Image size 1659x2212, camera: Remidio Fundus on Phone (FOP) camera:
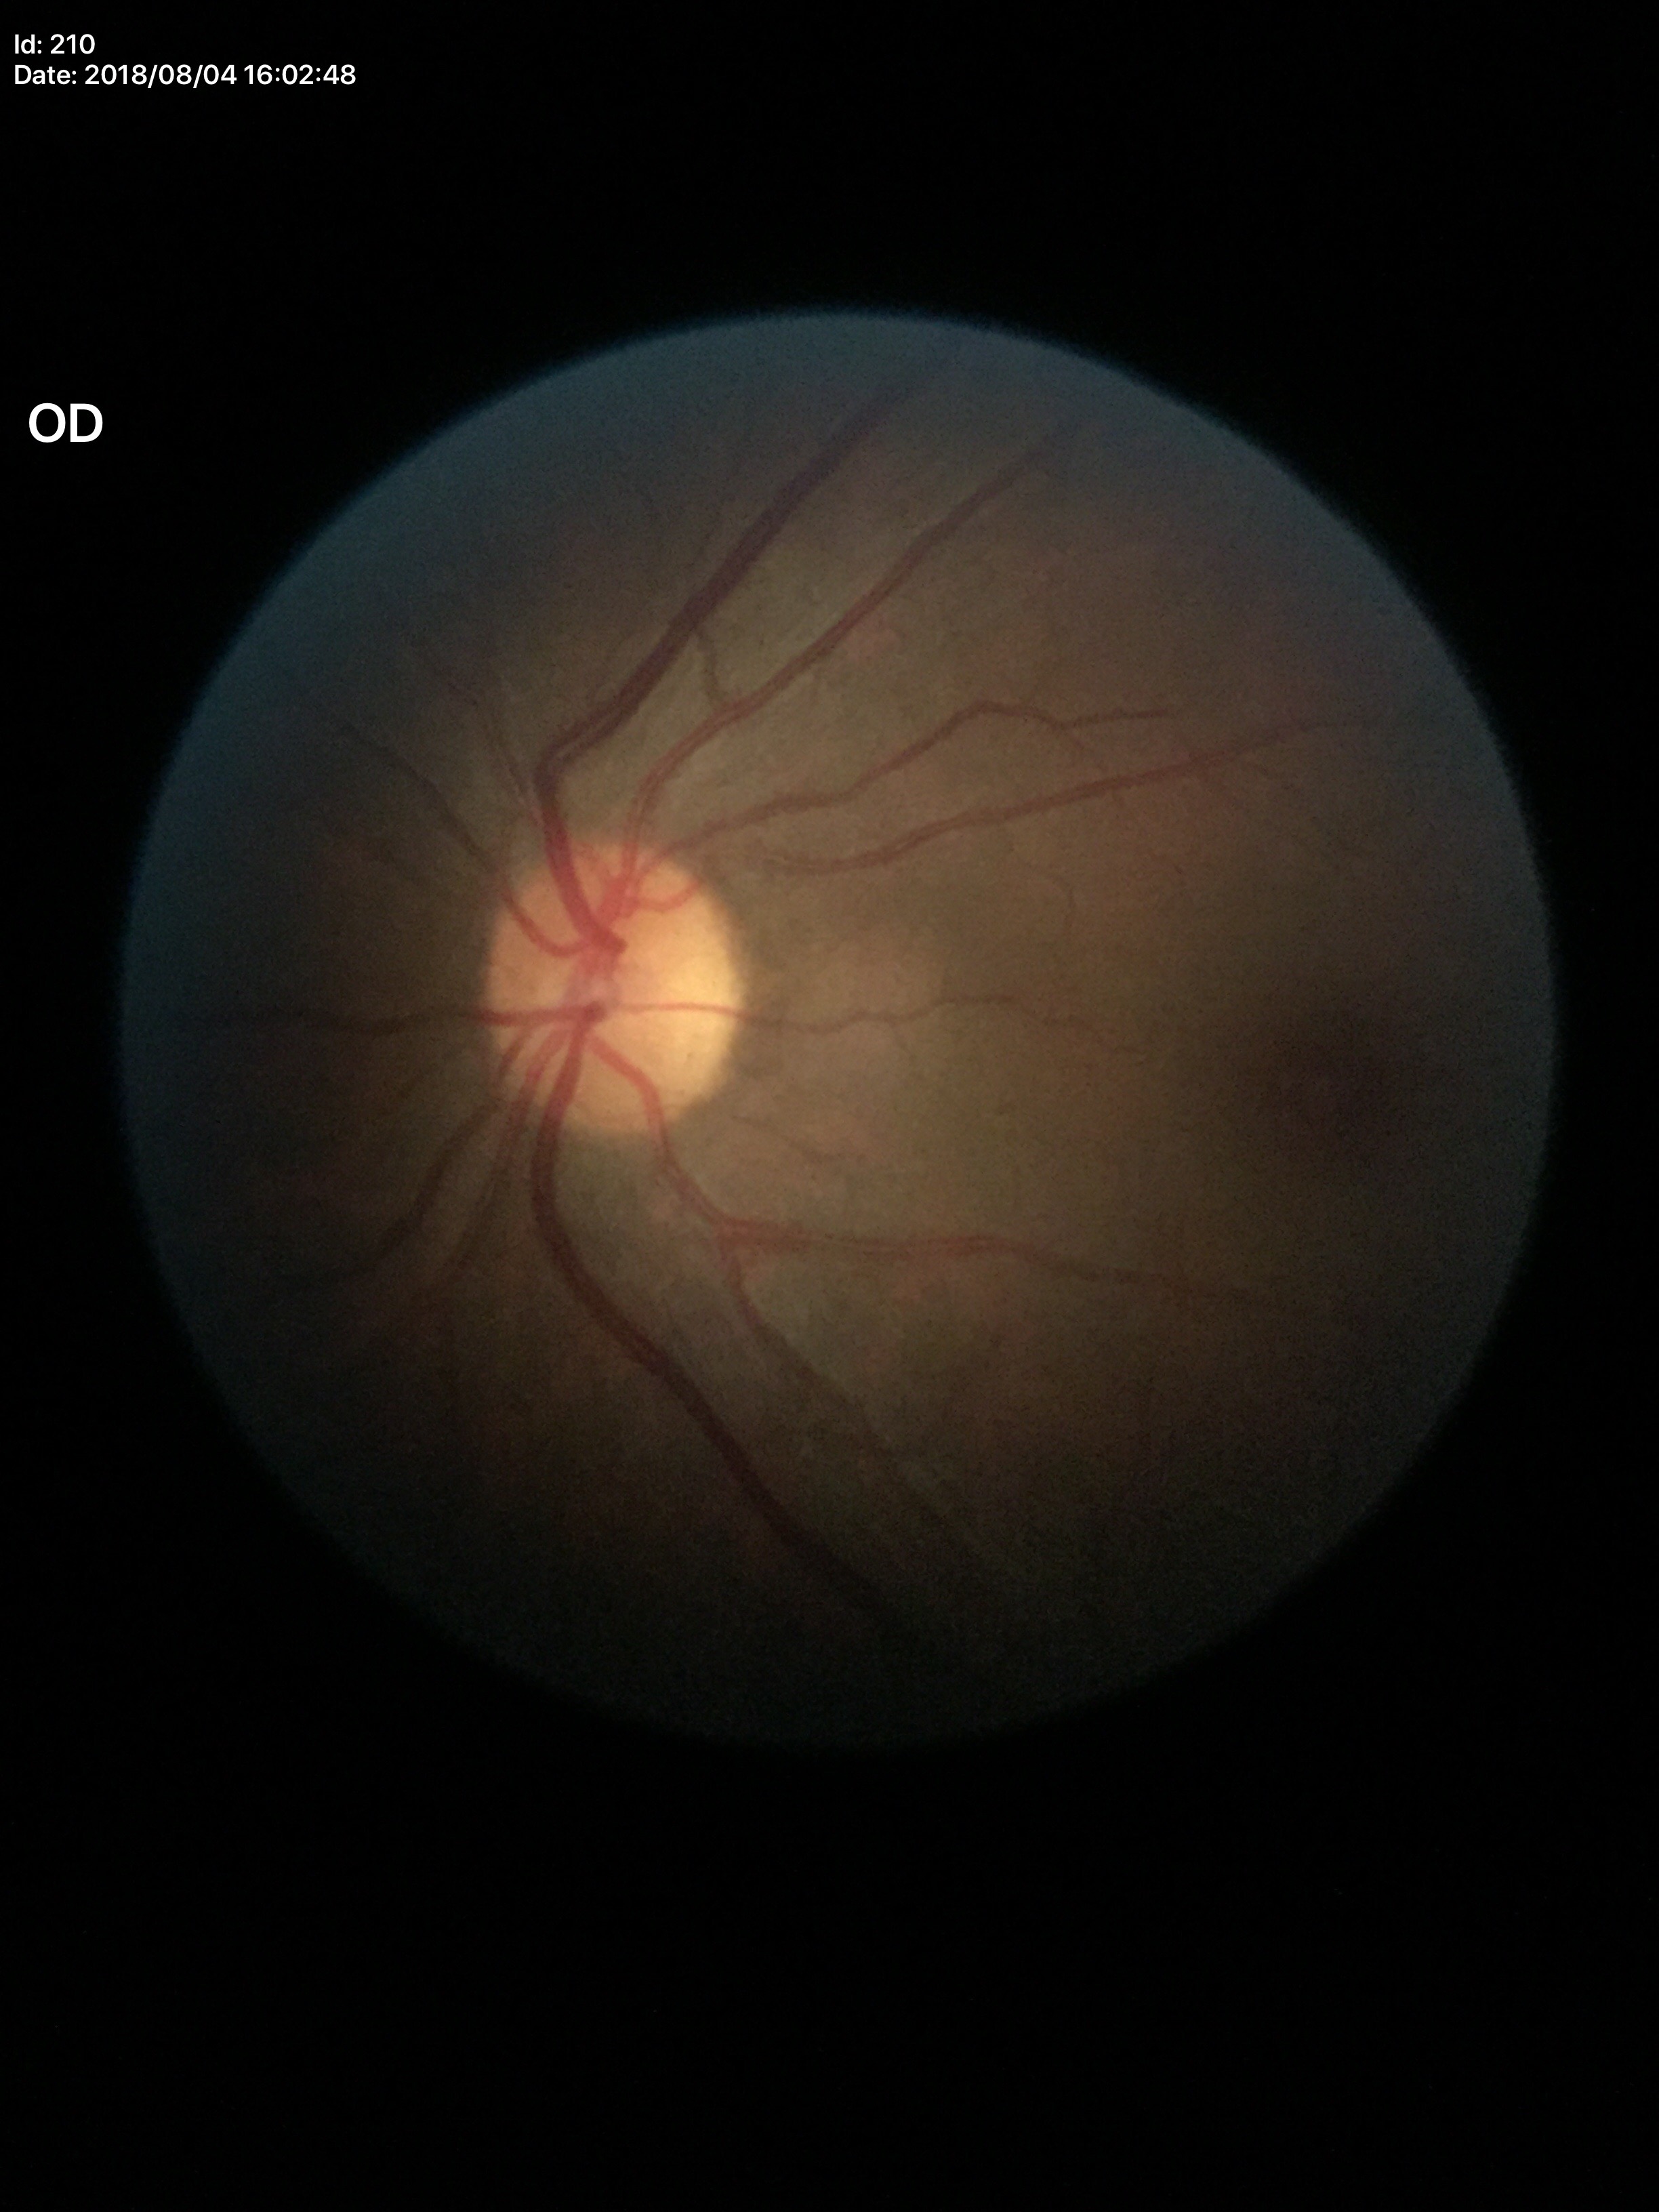 Glaucoma screening impression: no suspicious findings (unanimous normal call) | horizontal C/D ratio: 0.46 | vertical CDR: 0.49